DR severity per modified Davis staging.
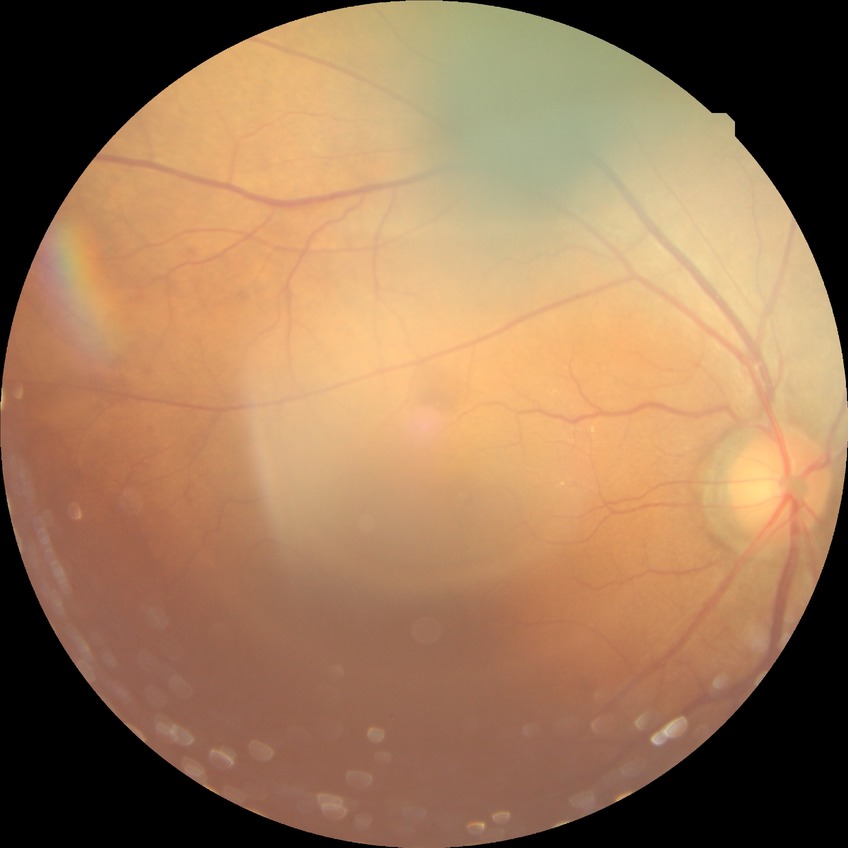 Diabetic retinopathy (DR) is no diabetic retinopathy (NDR).